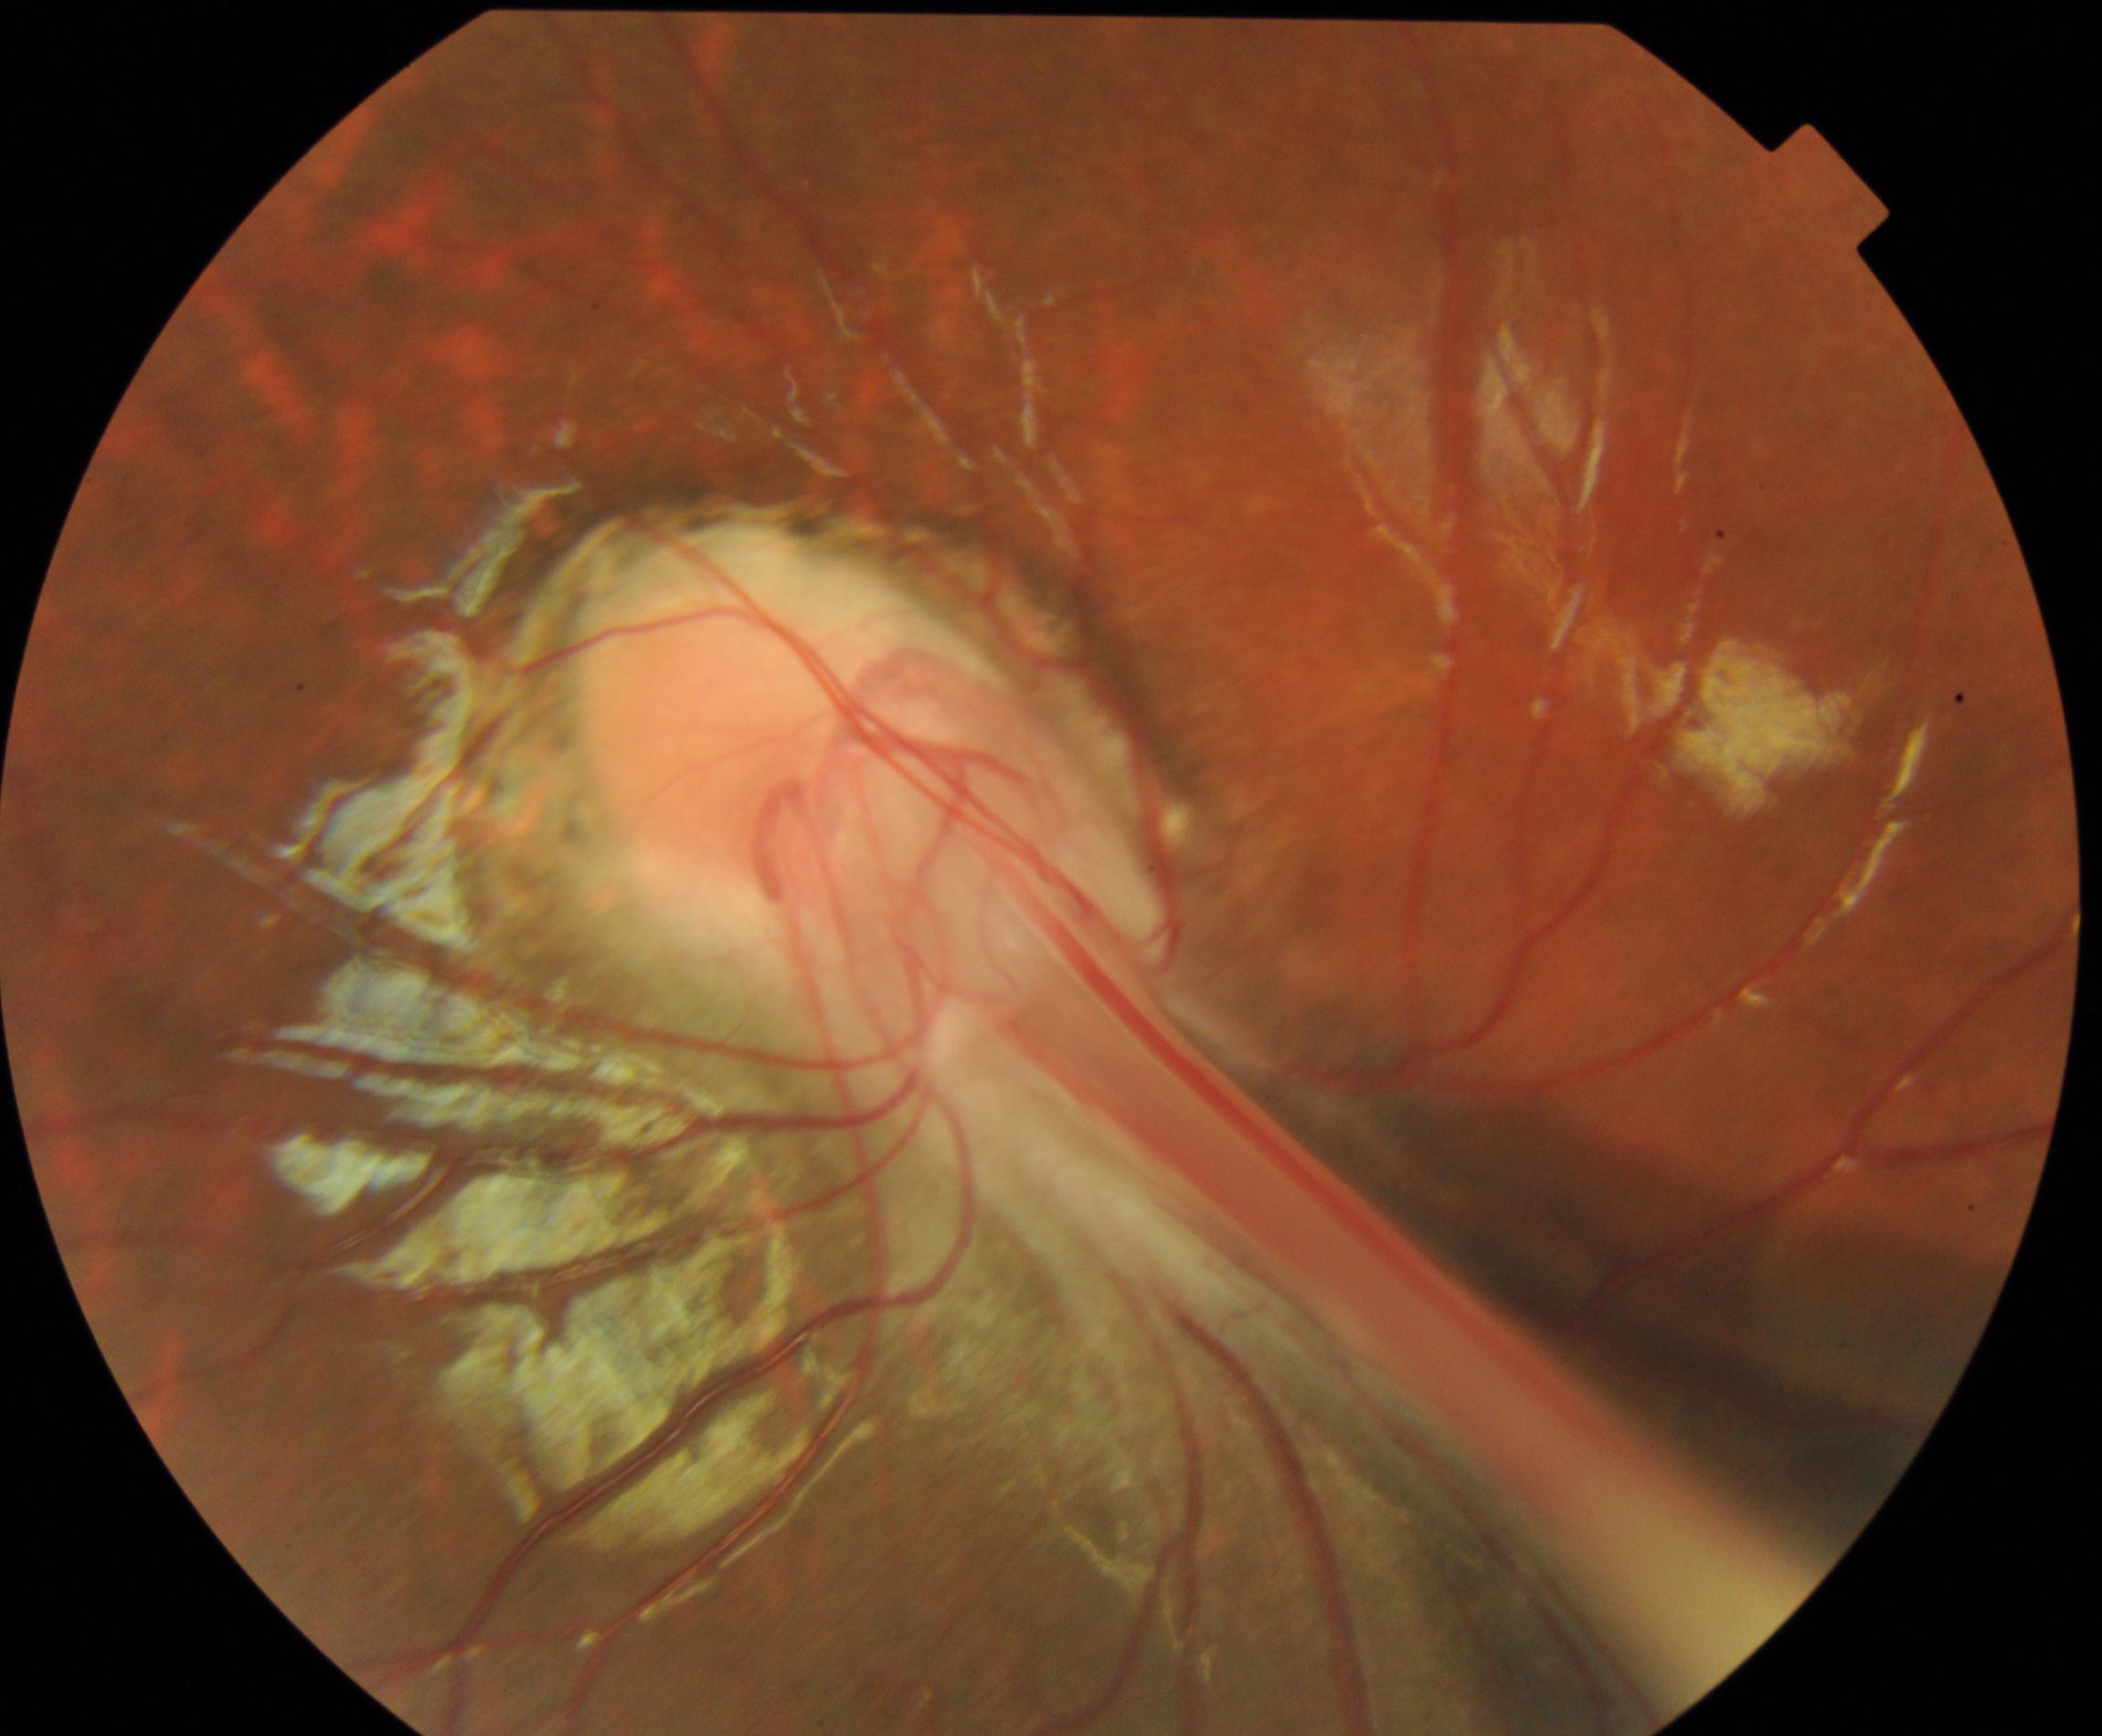 Primary finding: dragged disc.